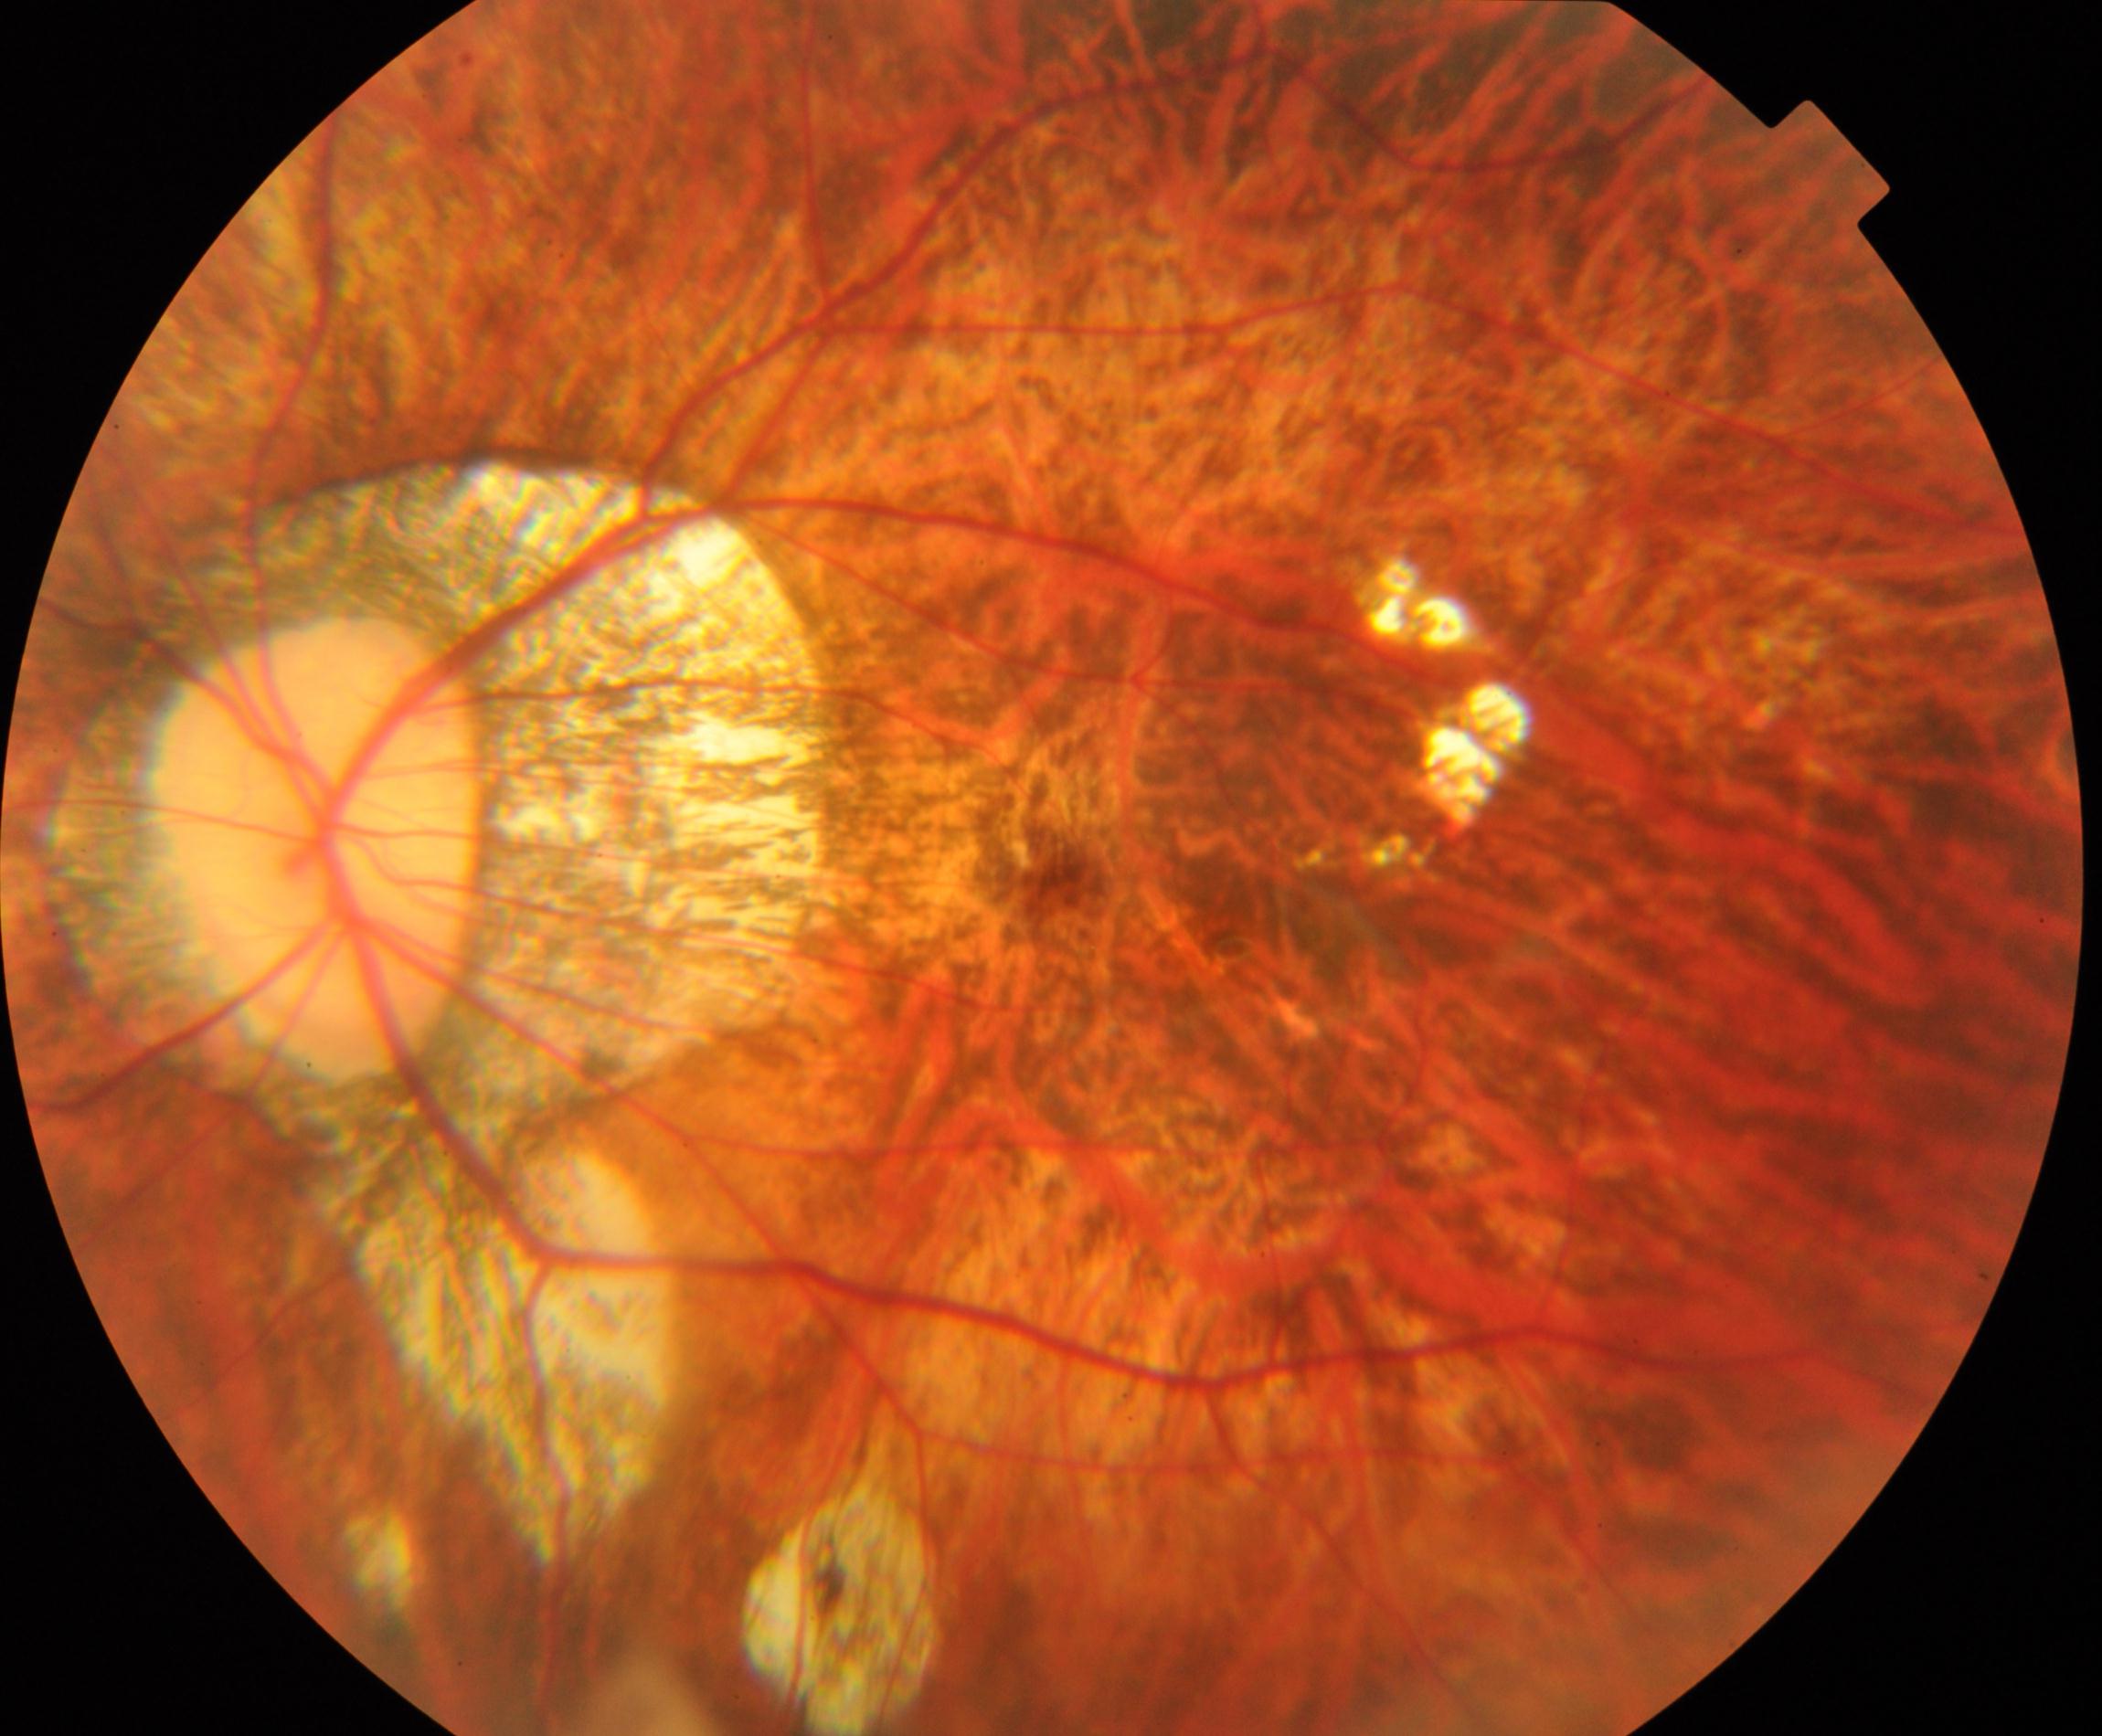
Impression: pathological myopia.